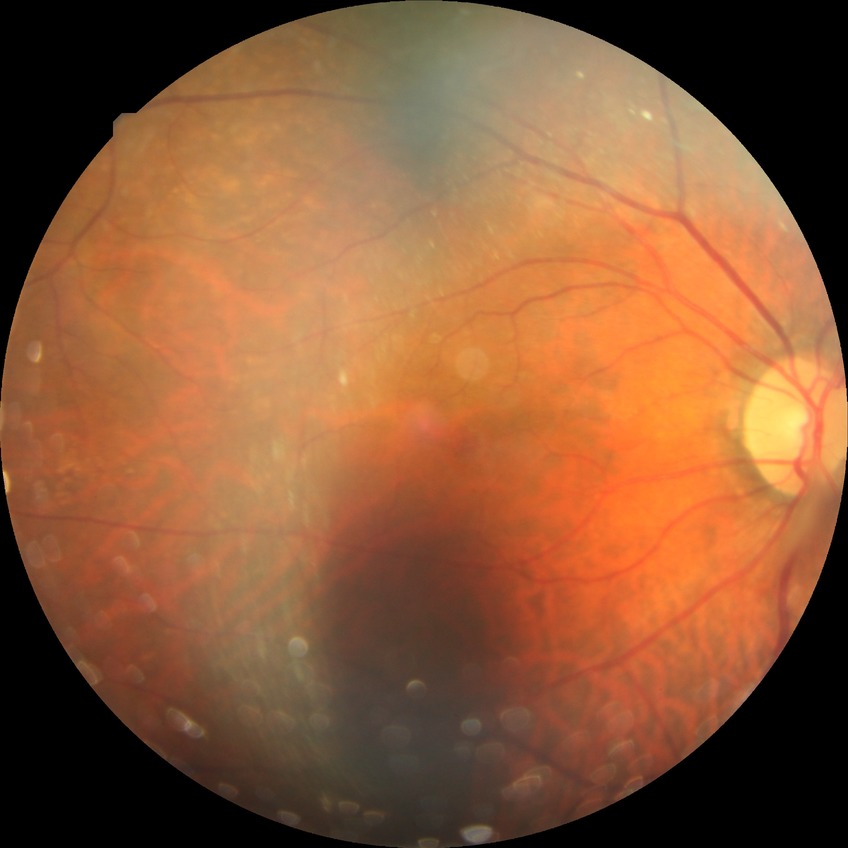 {
  "davis_grade": "no diabetic retinopathy"
}